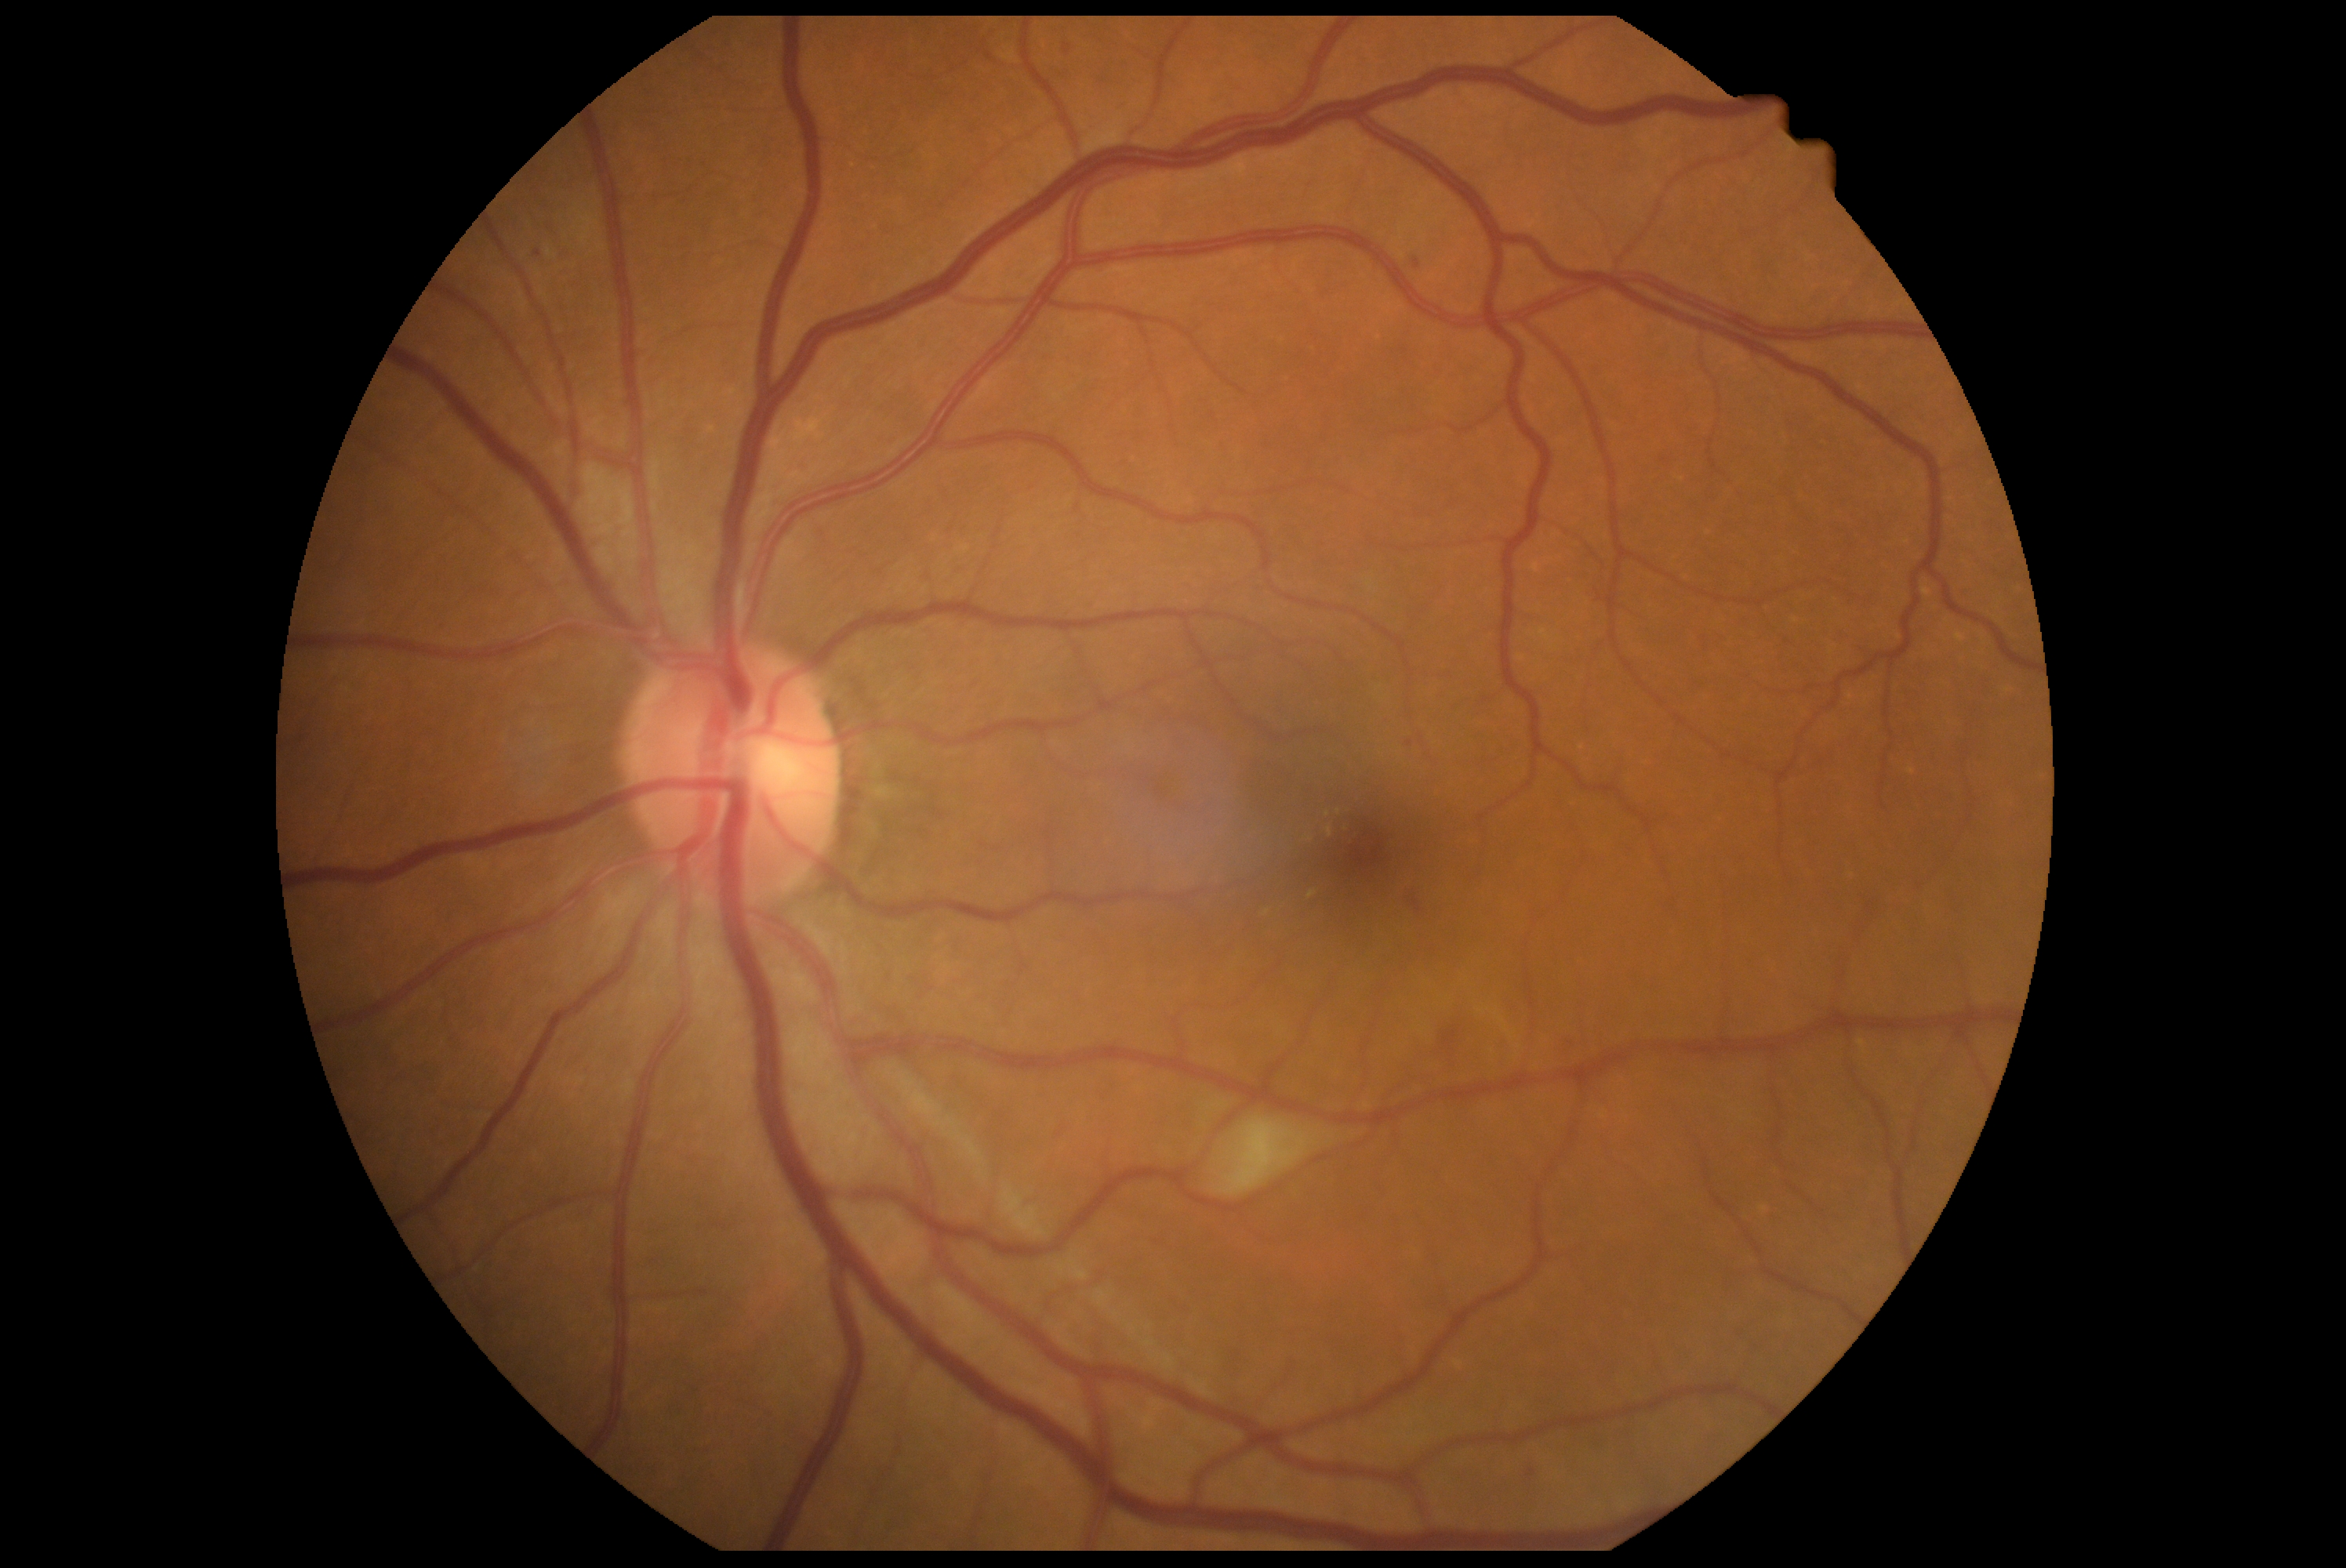

DR class = non-proliferative diabetic retinopathy, DR stage = 2 — more than just microaneurysms but less than severe NPDR.